DR severity per modified Davis staging
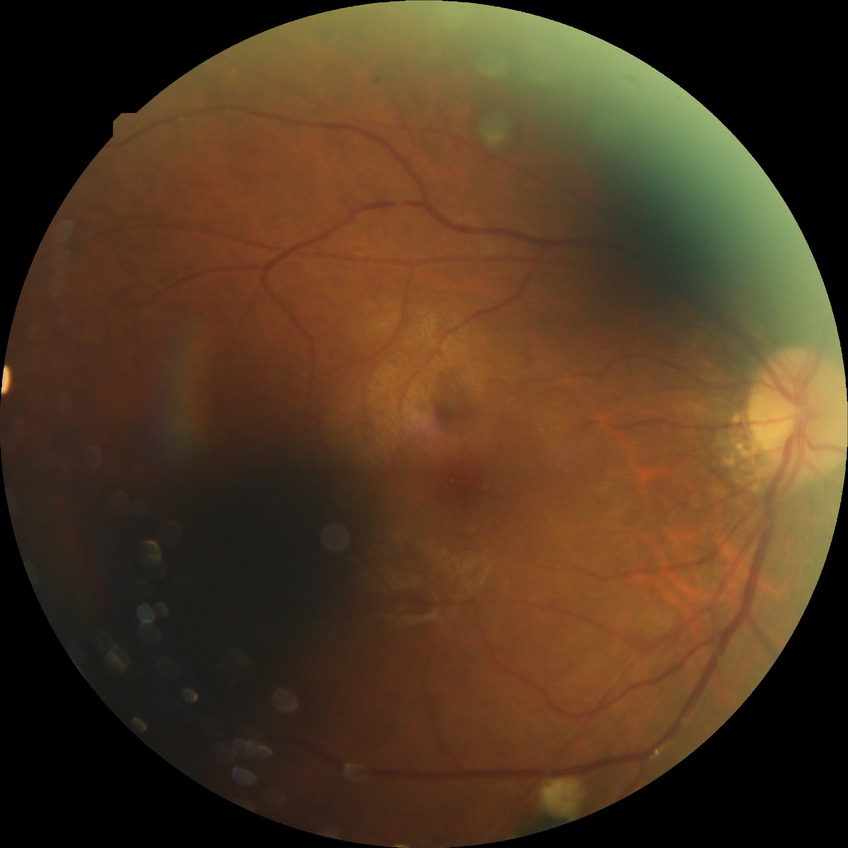

diabetic retinopathy (DR): PDR (proliferative diabetic retinopathy)